Infant wide-field retinal image; camera: Phoenix ICON (100° FOV); 1240x1240px:
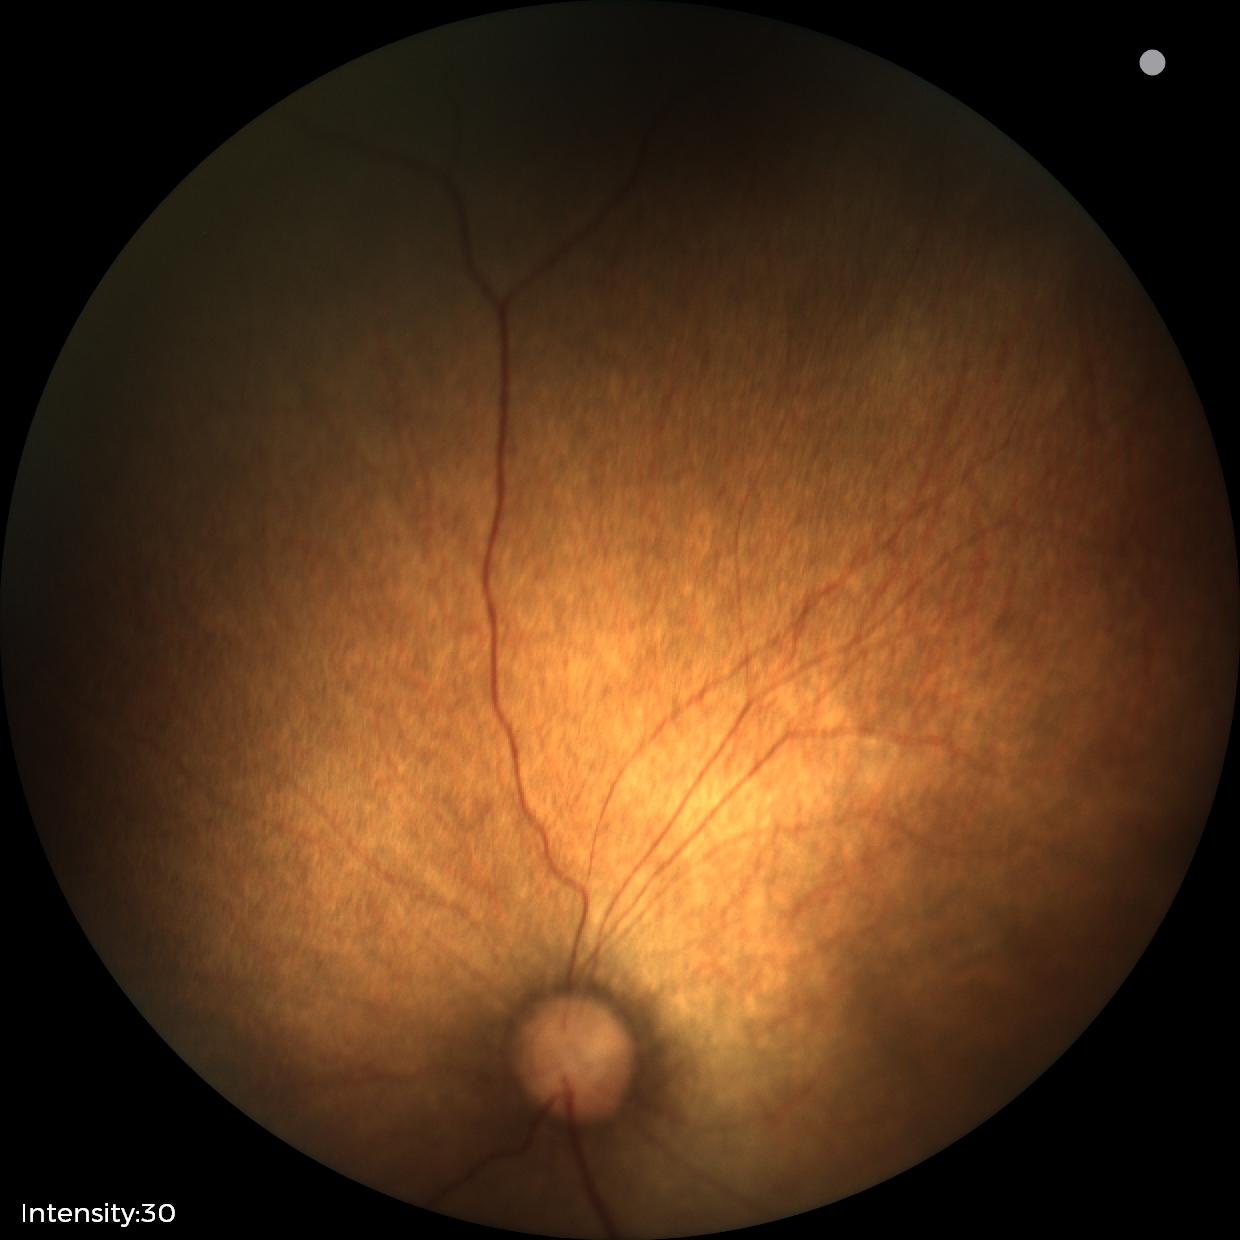 Impression = physiological appearance.